45-degree field of view · color fundus image
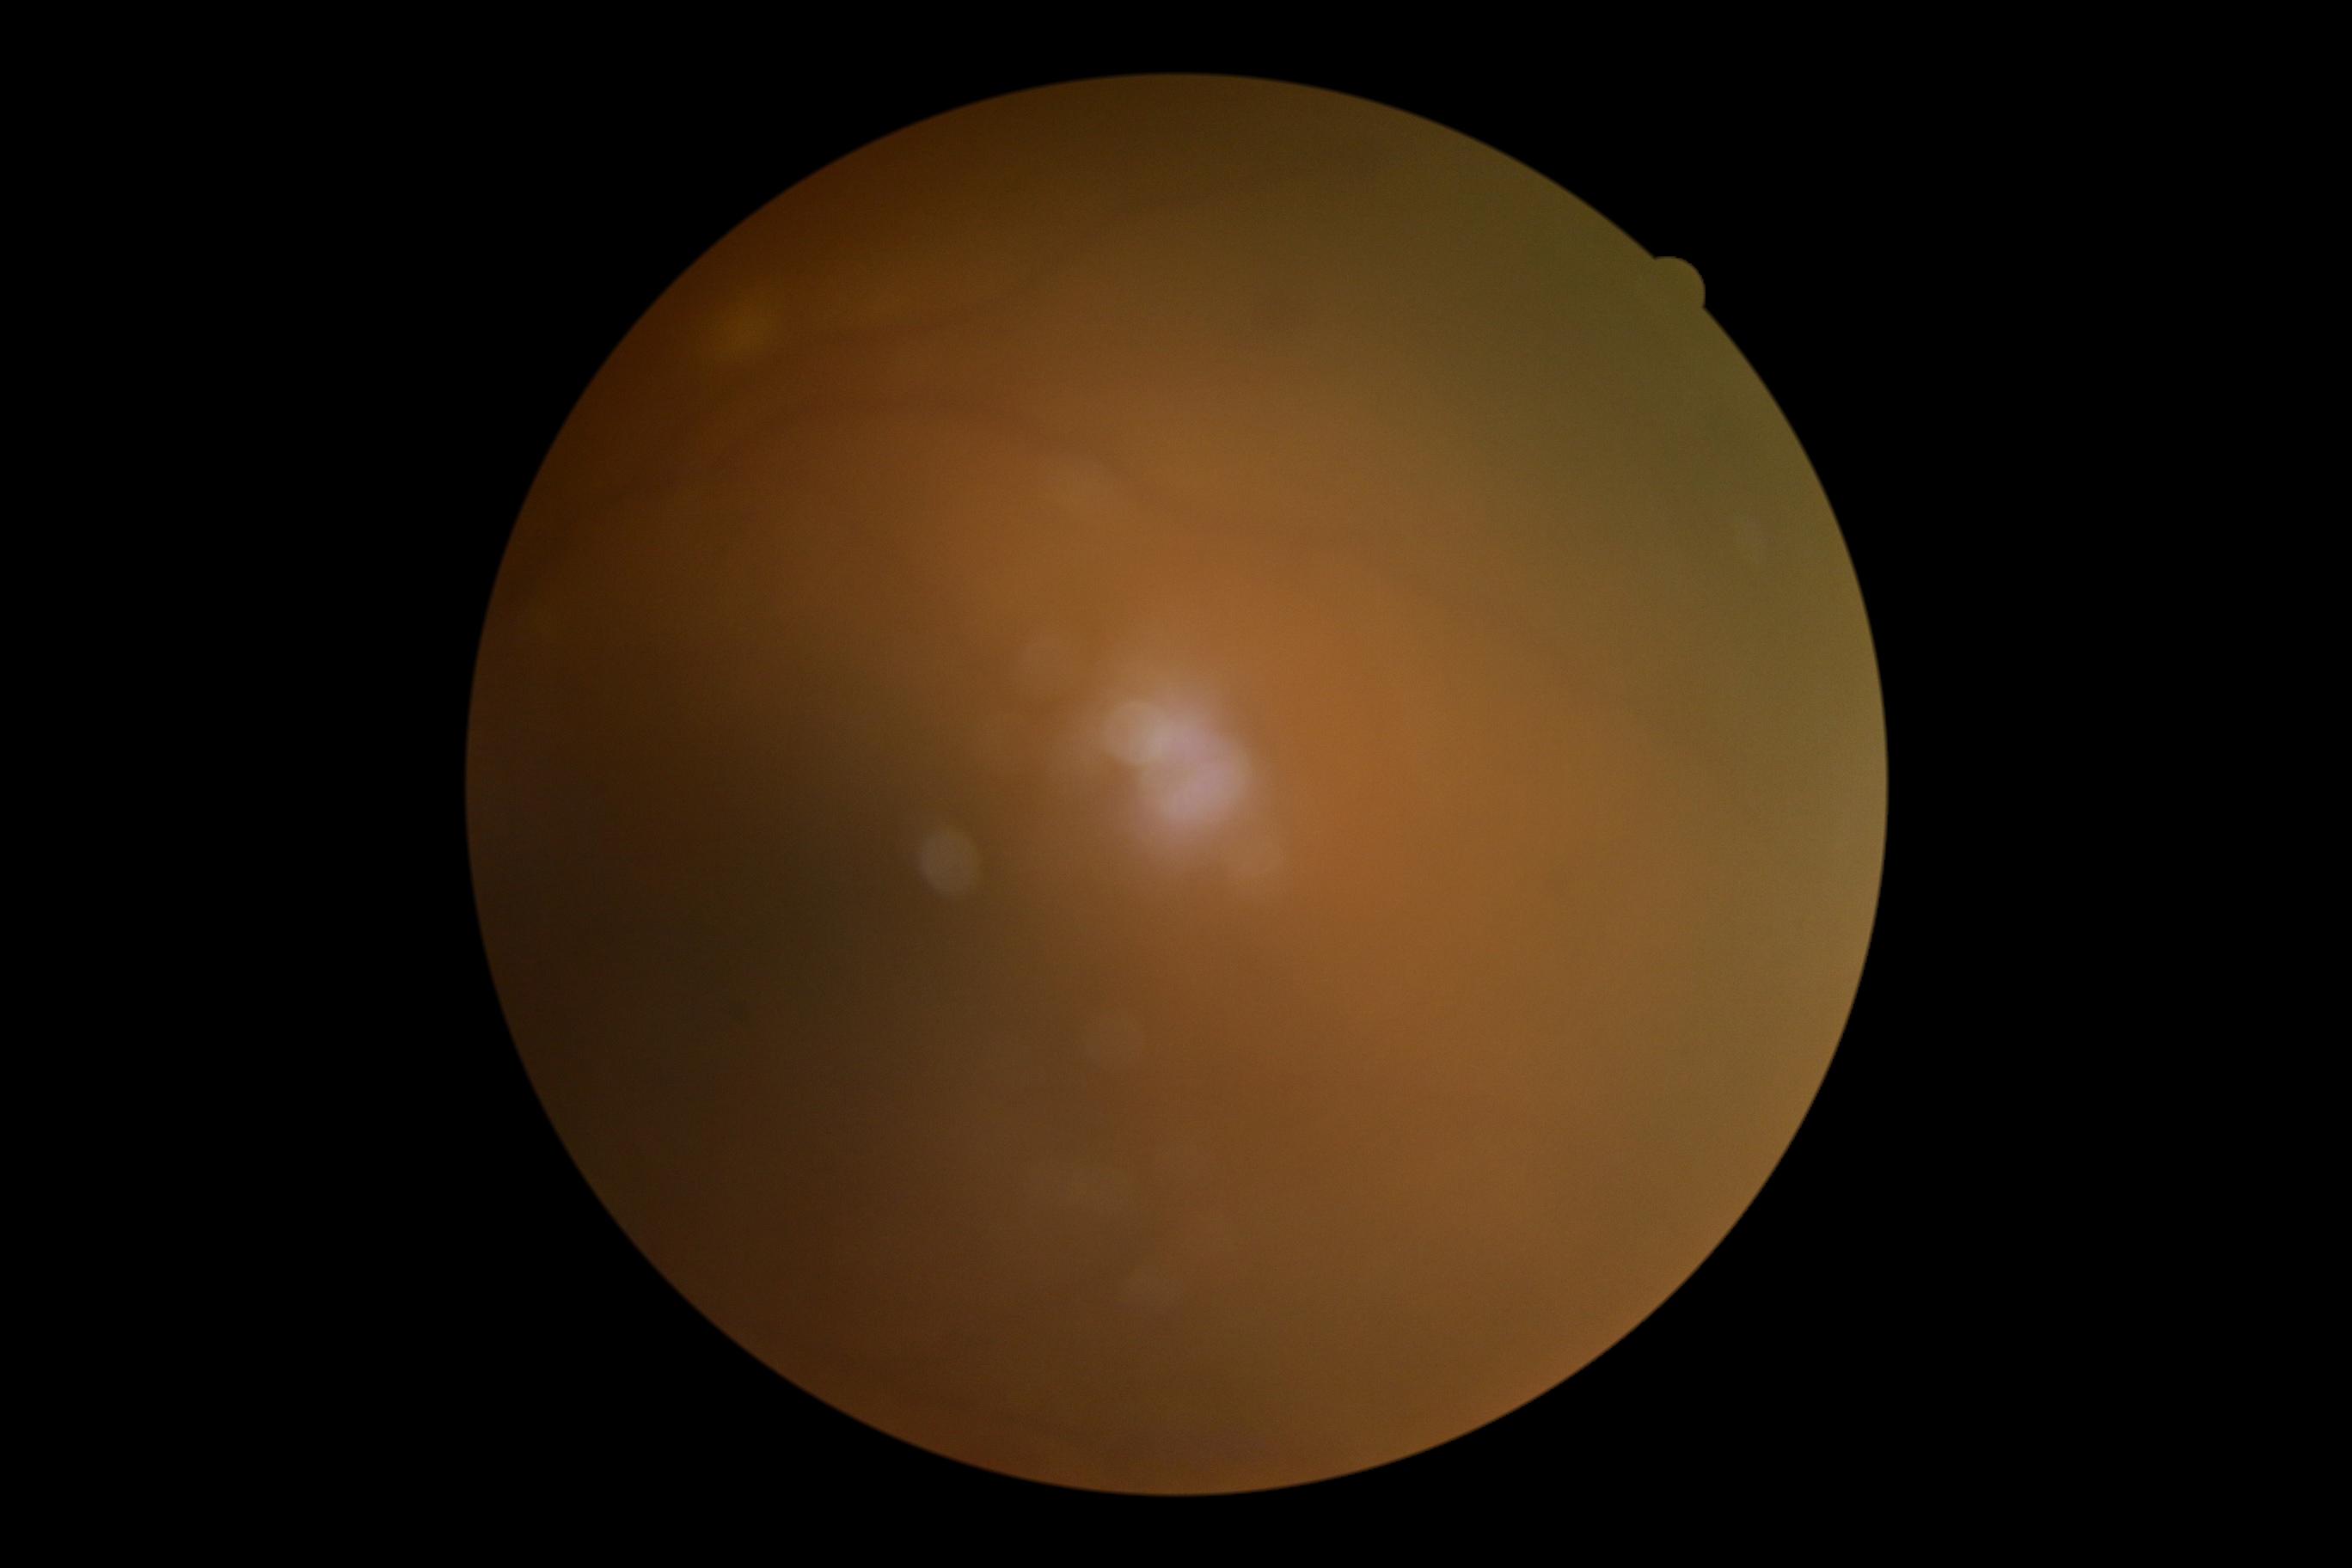 DR grade=ungradable due to poor image quality.